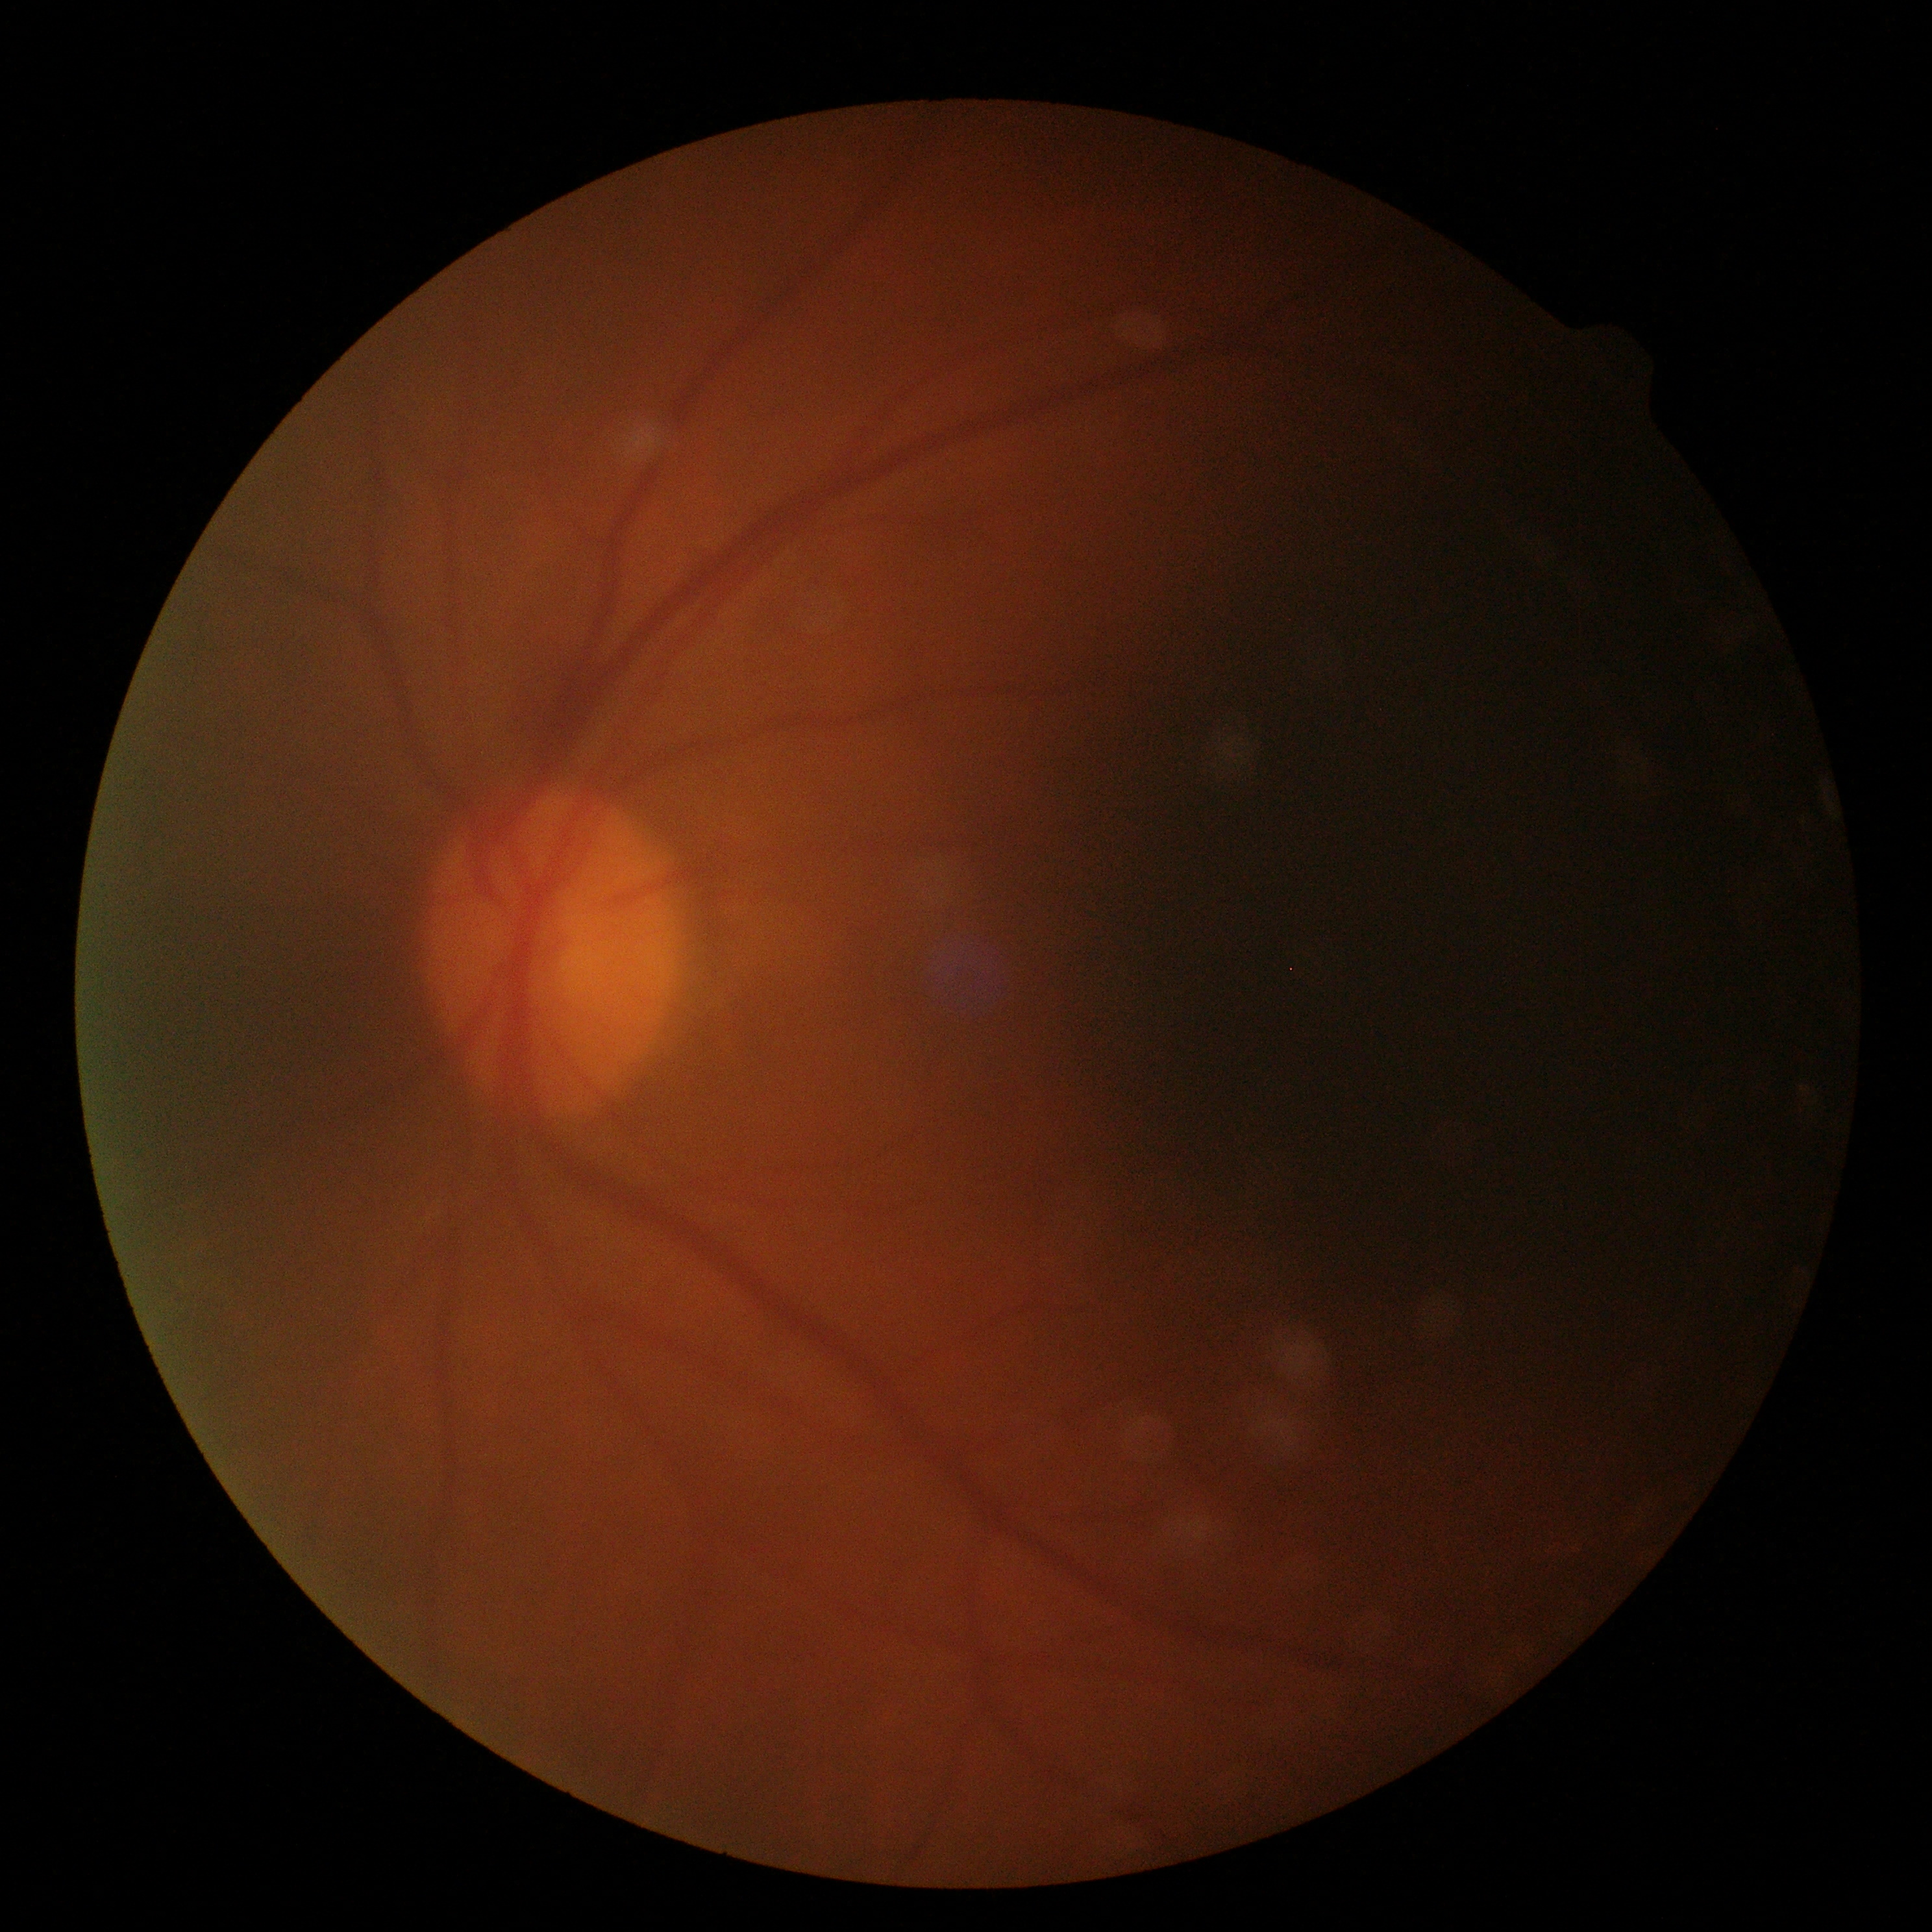 No apparent diabetic retinopathy.
DR stage is 0/4.